Color fundus photograph, acquired with a NIDEK AFC-230
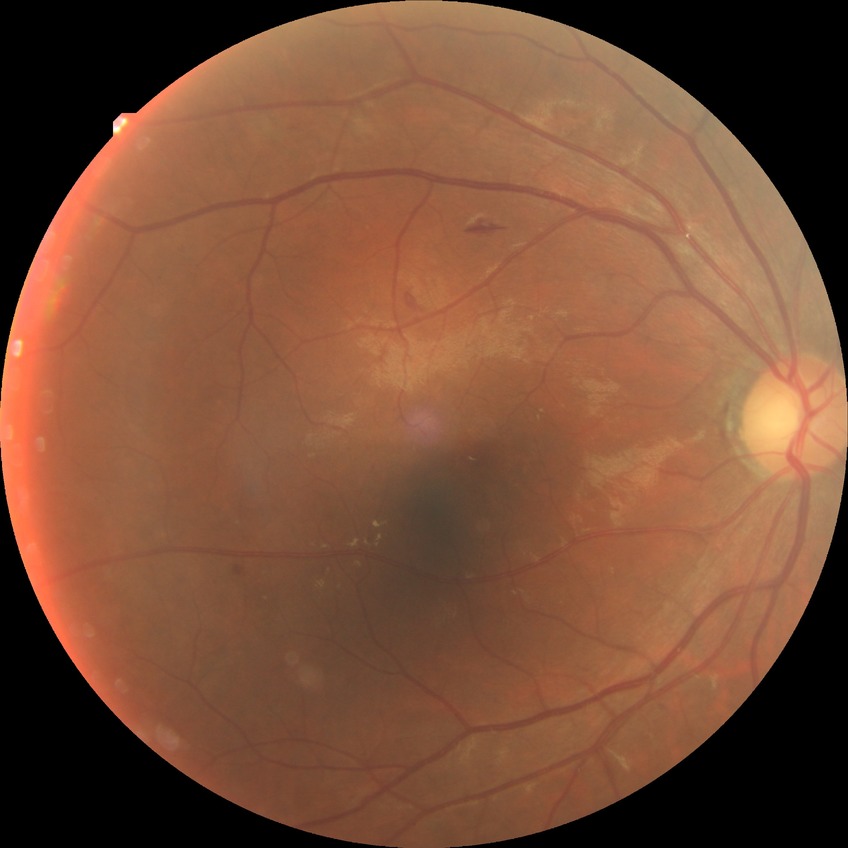 Diabetic retinopathy stage is simple diabetic retinopathy.